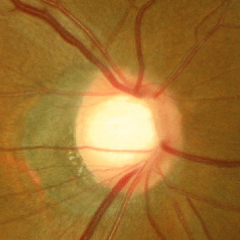
Glaucoma status = early glaucomatous optic neuropathy.